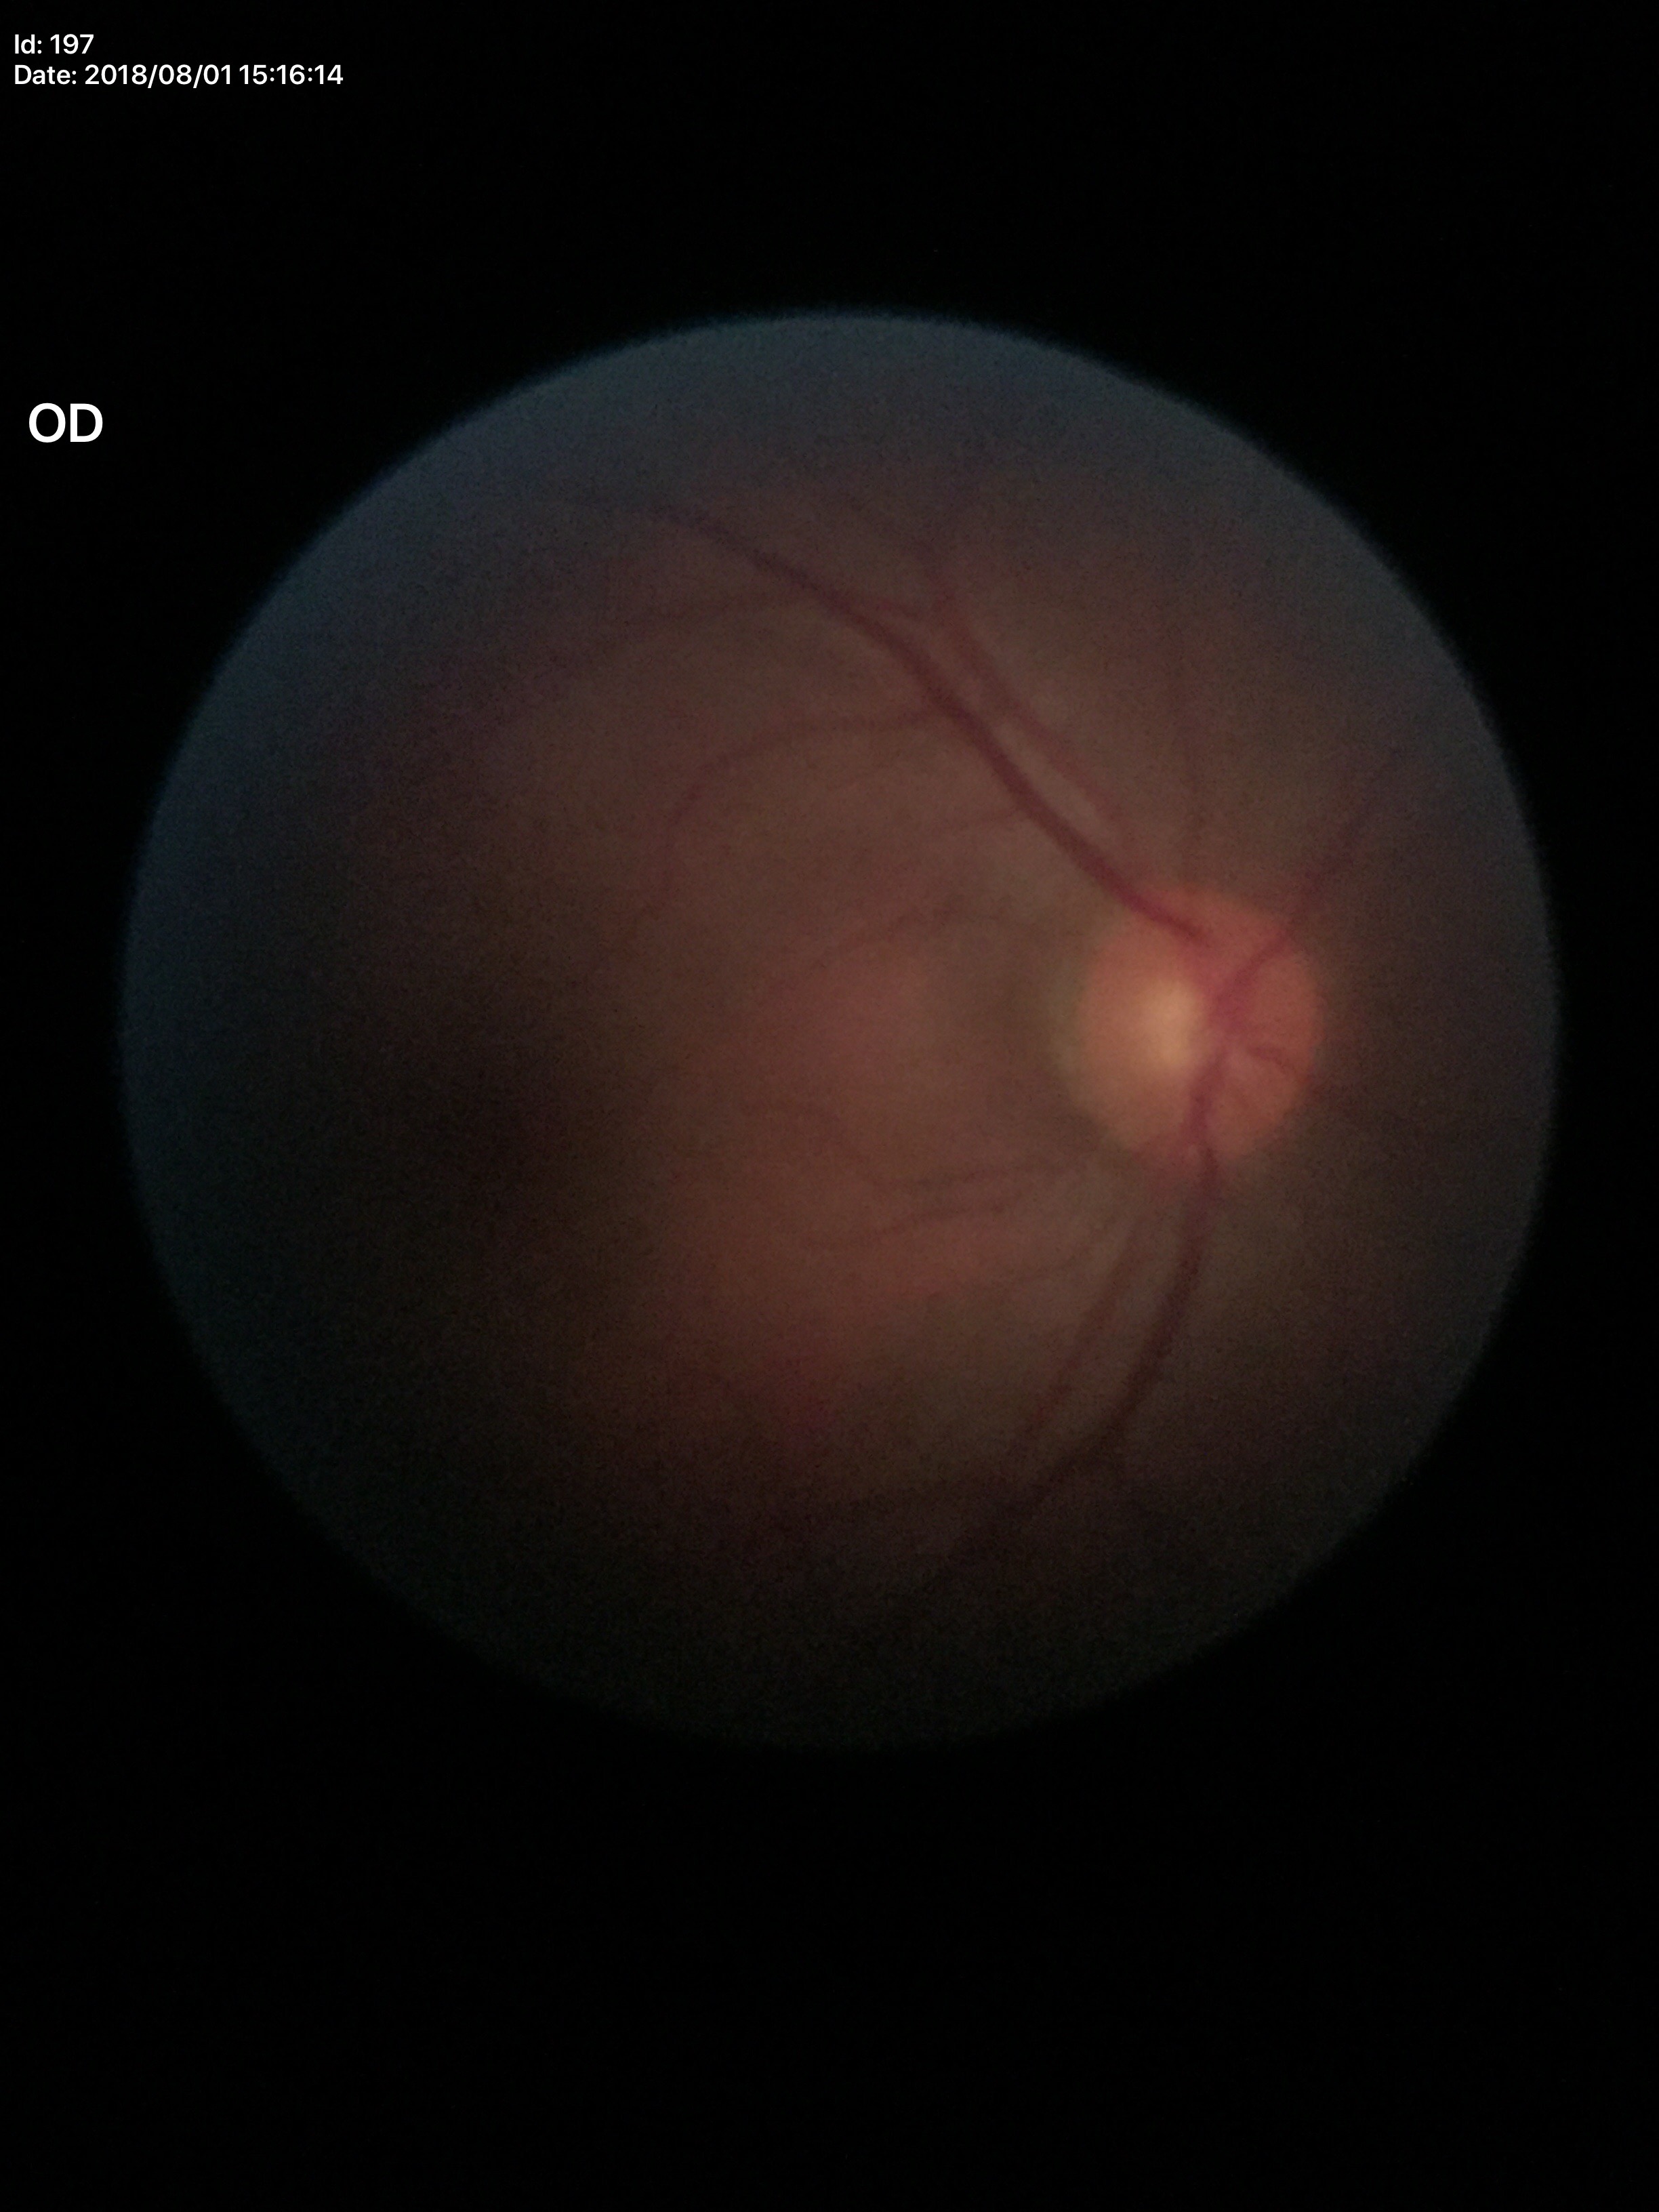
VCDR of 0.51. ACDR of 0.24. Glaucoma impression: not suspect (all 5 graders called normal).